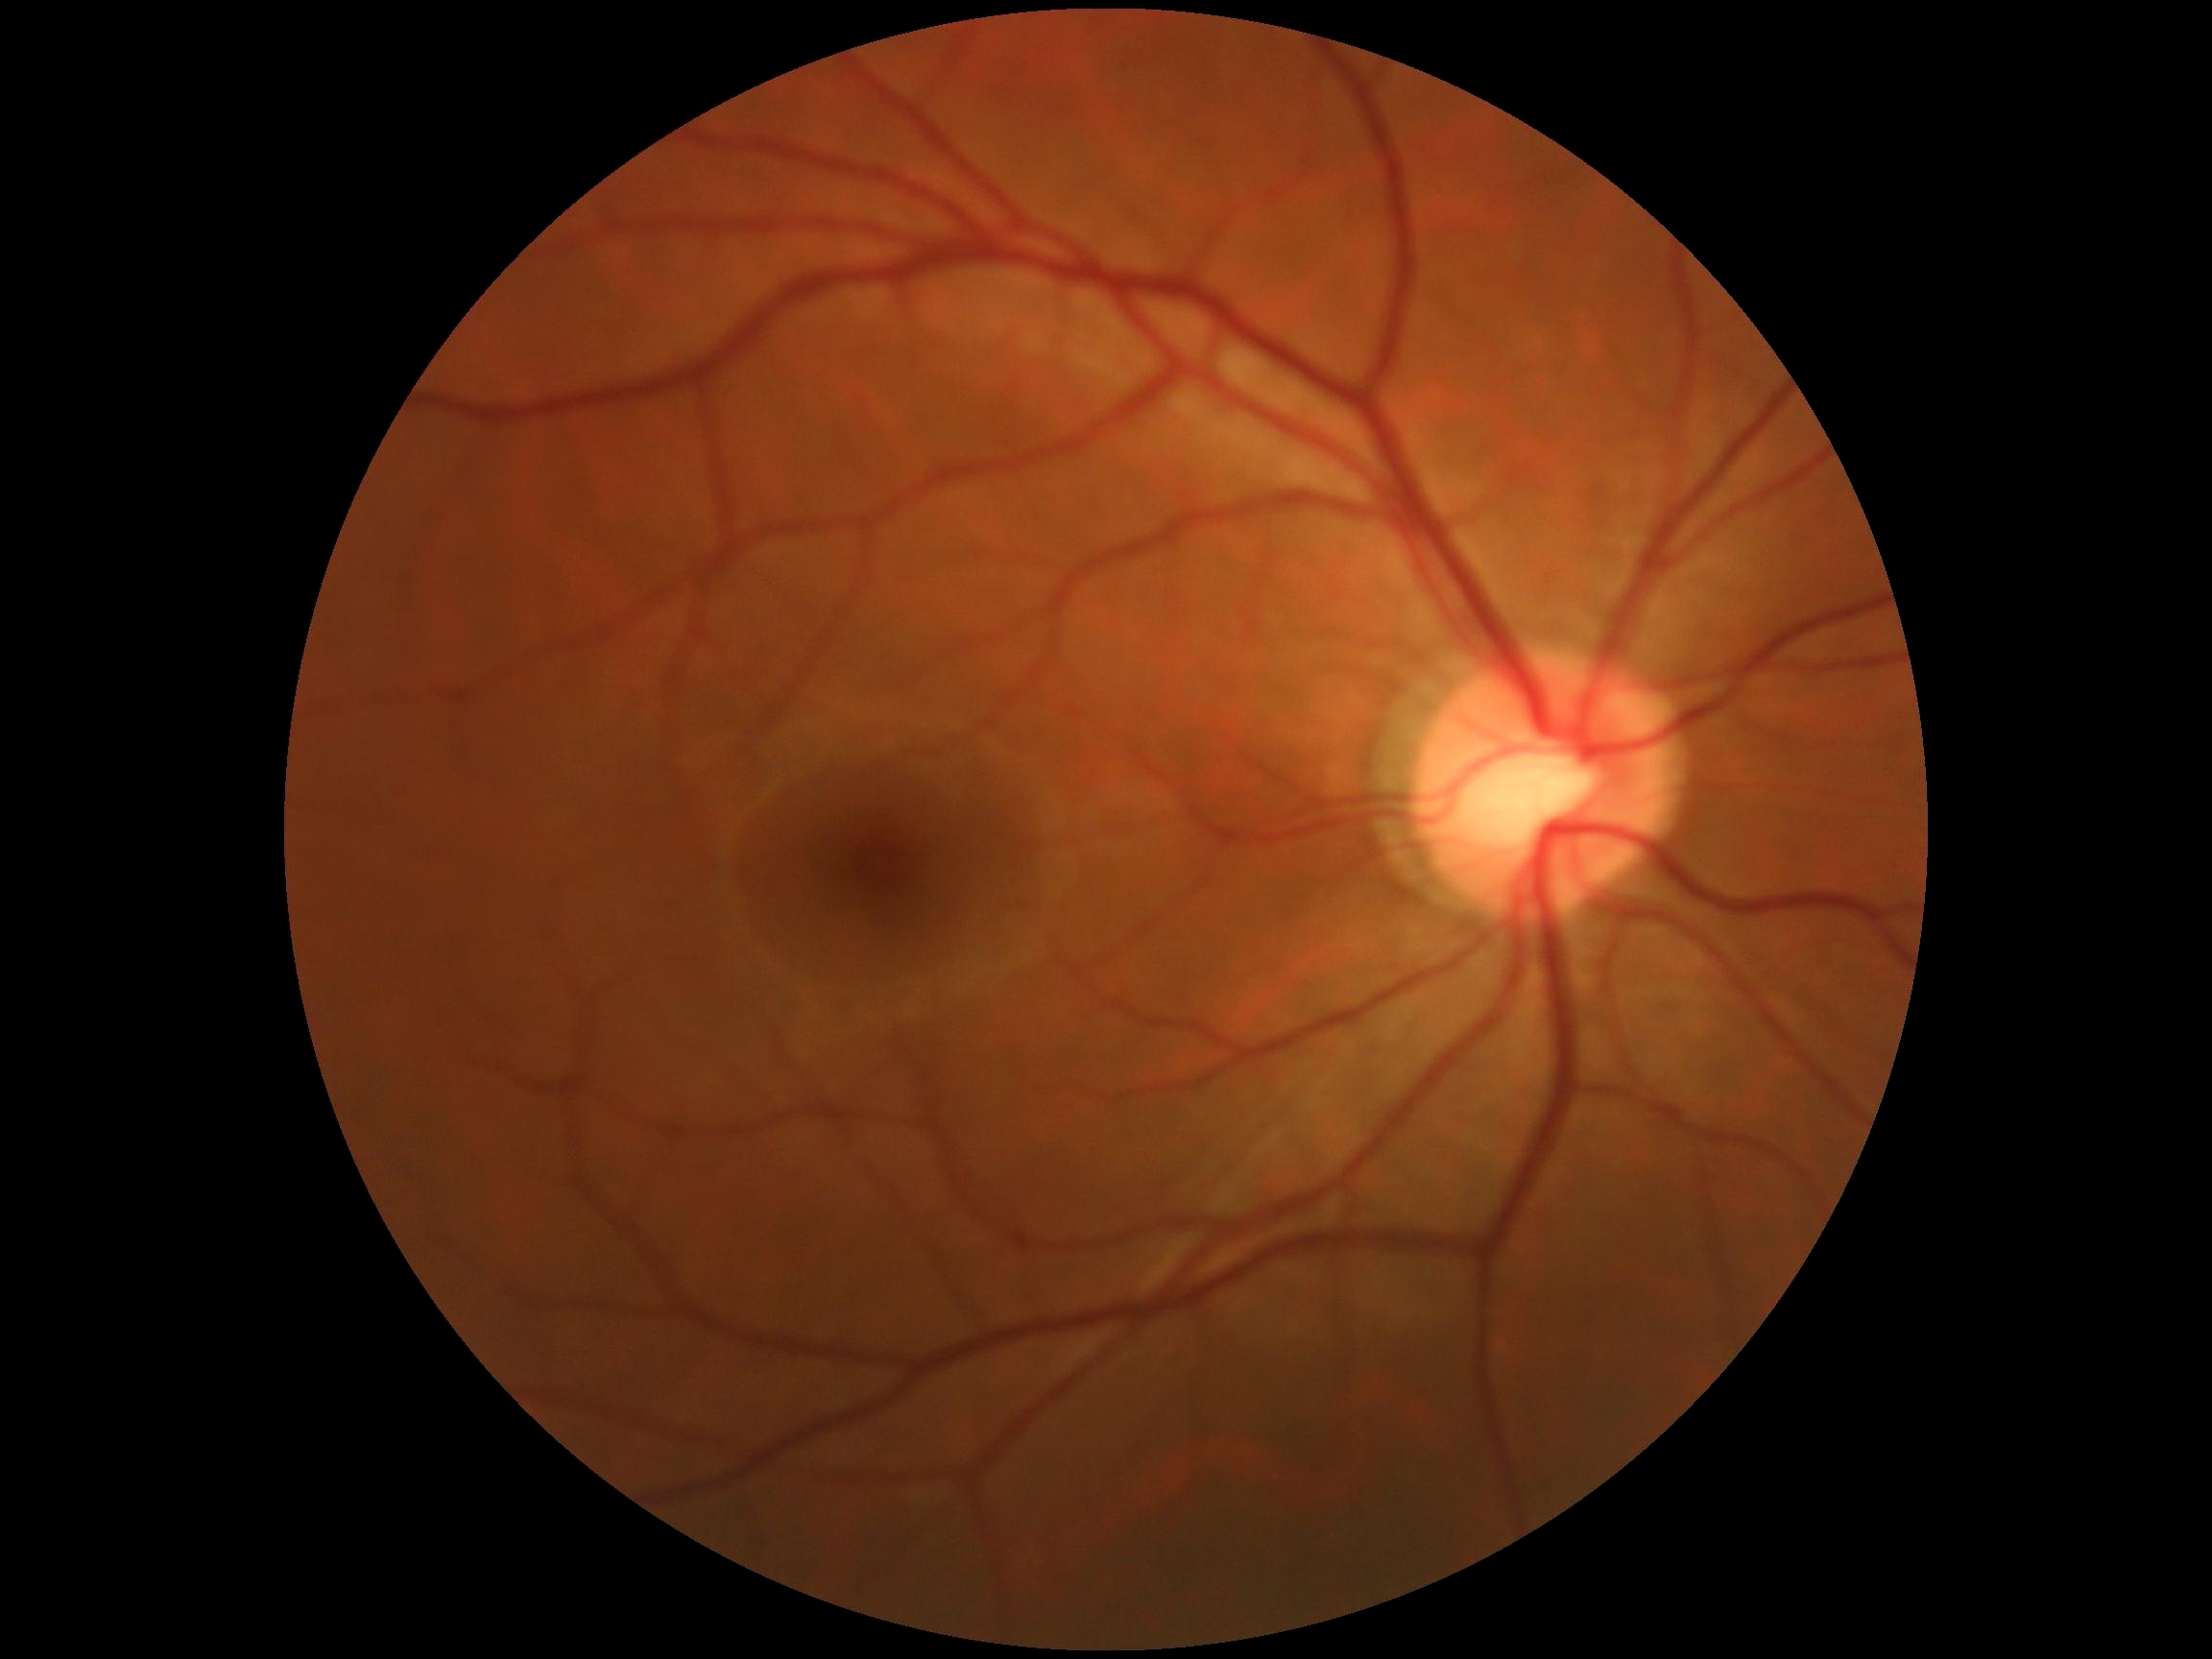
Diabetic retinopathy grade: 0/4.